Wide-field contact fundus photograph of an infant · captured with the Natus RetCam Envision (130° field of view): 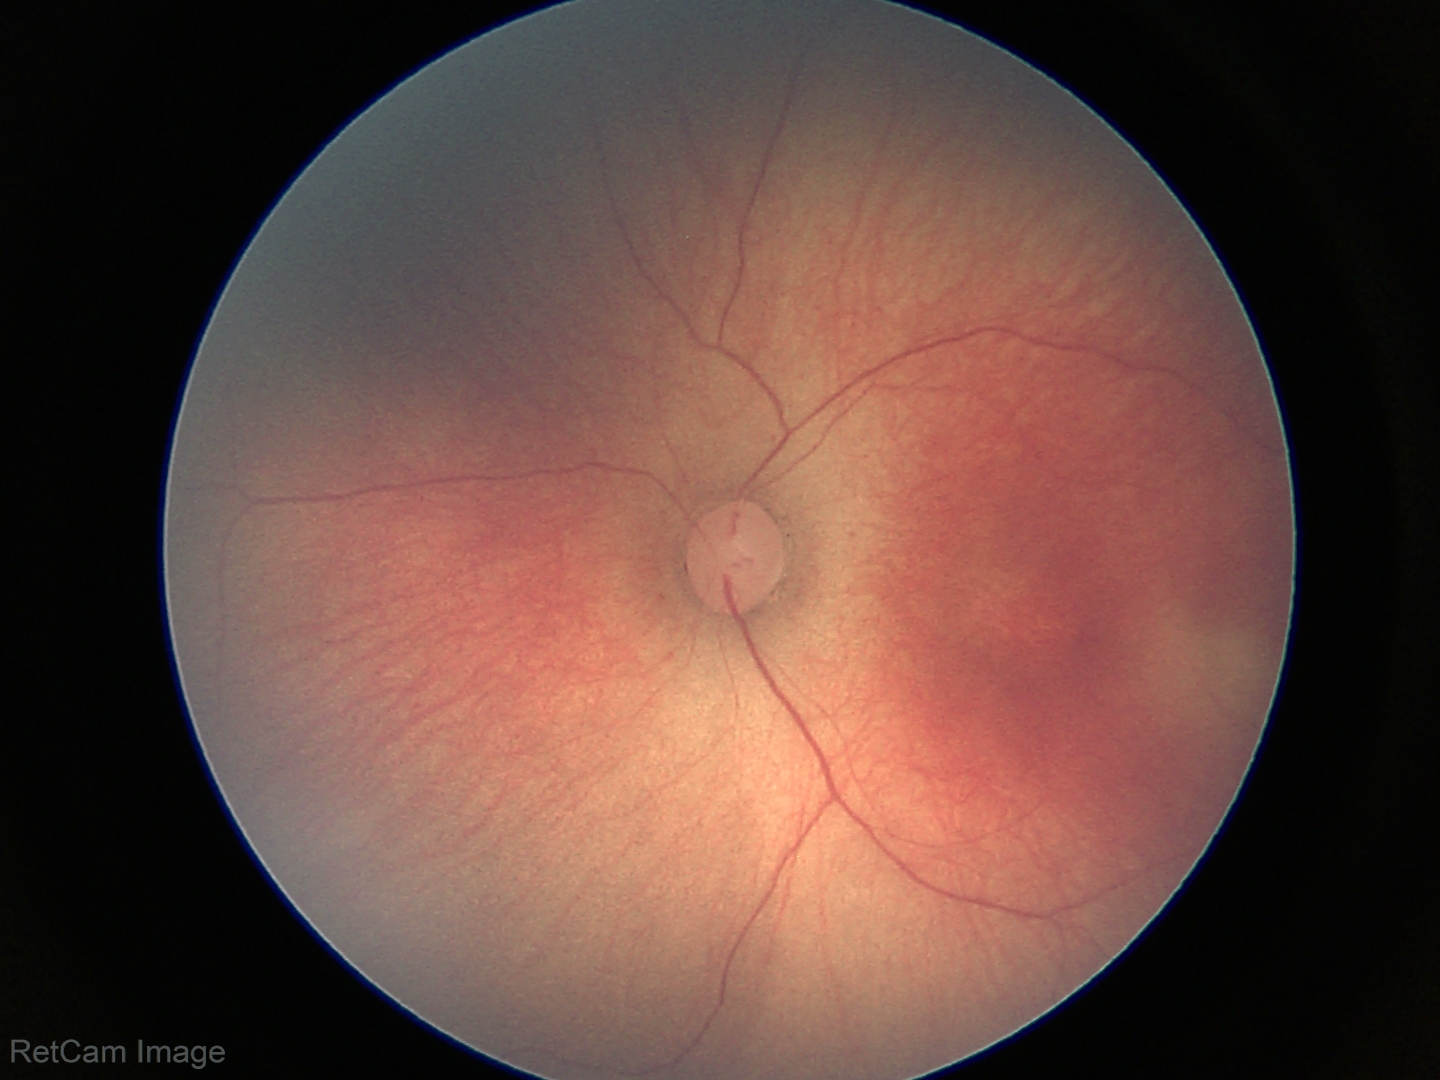 Series diagnosed as ROP stage 2. Plus disease absent.